45° FOV: 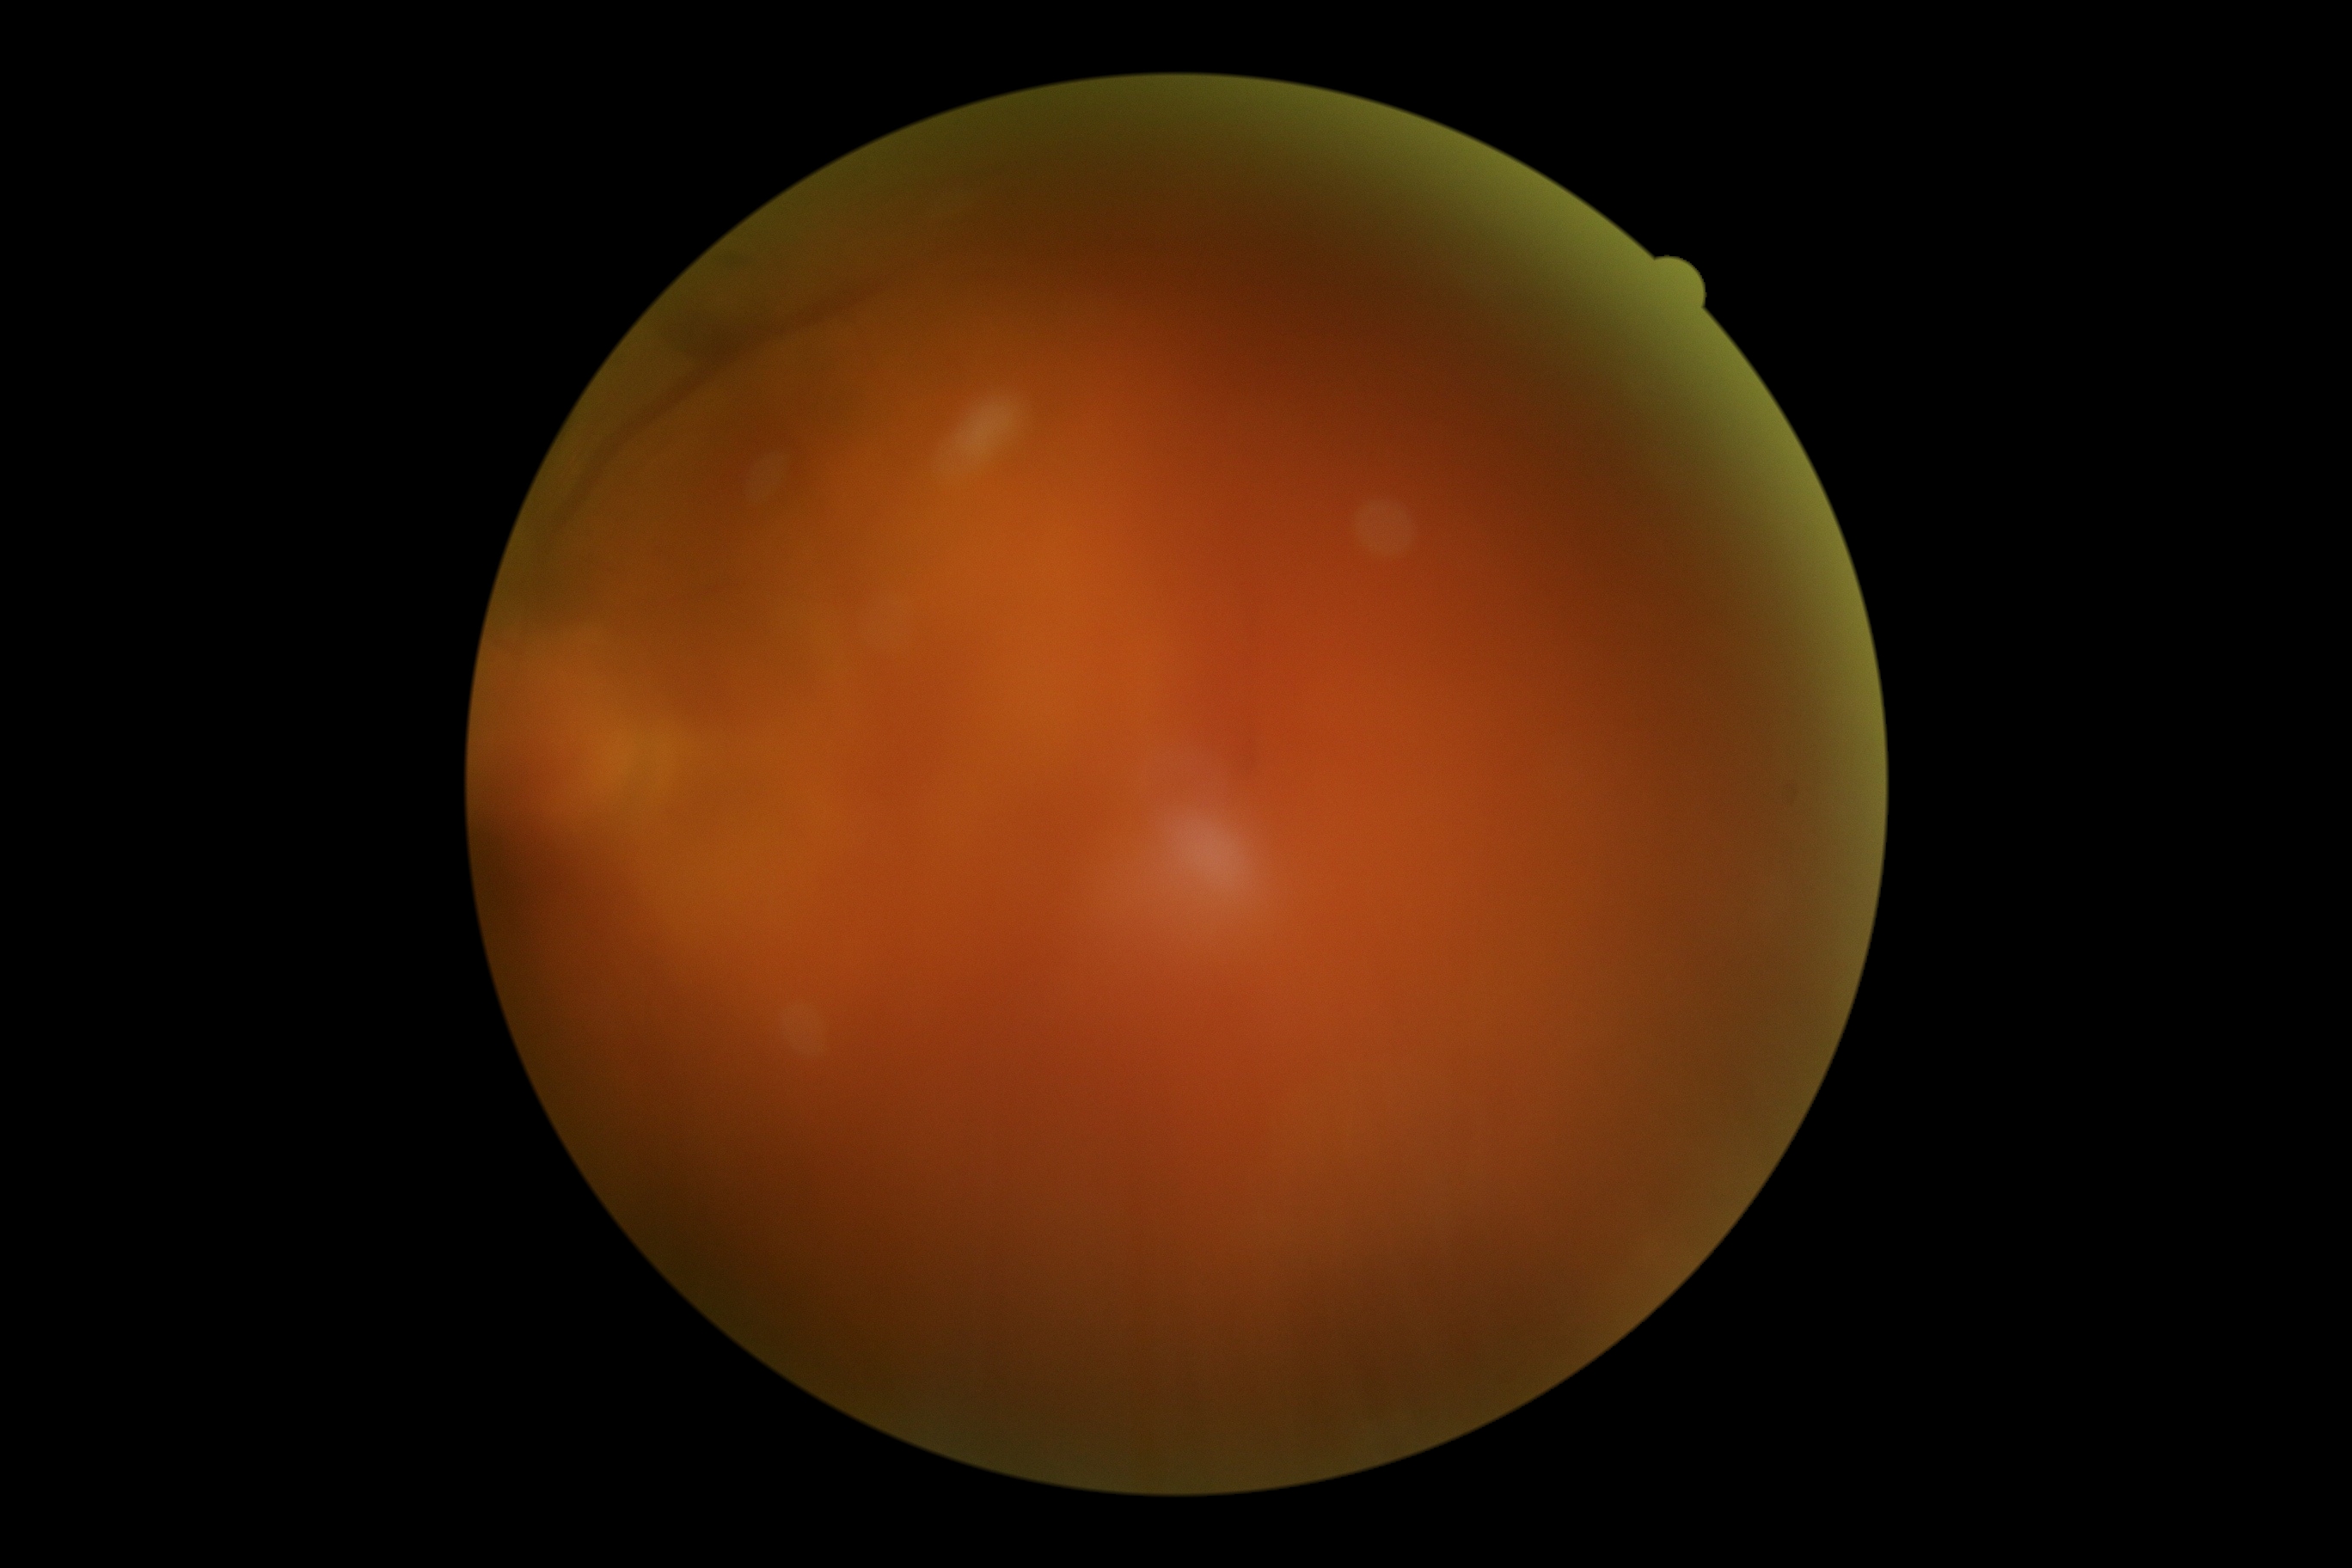
Annotations:
* retinopathy grade: ungradable due to poor image quality